2352x1568px — 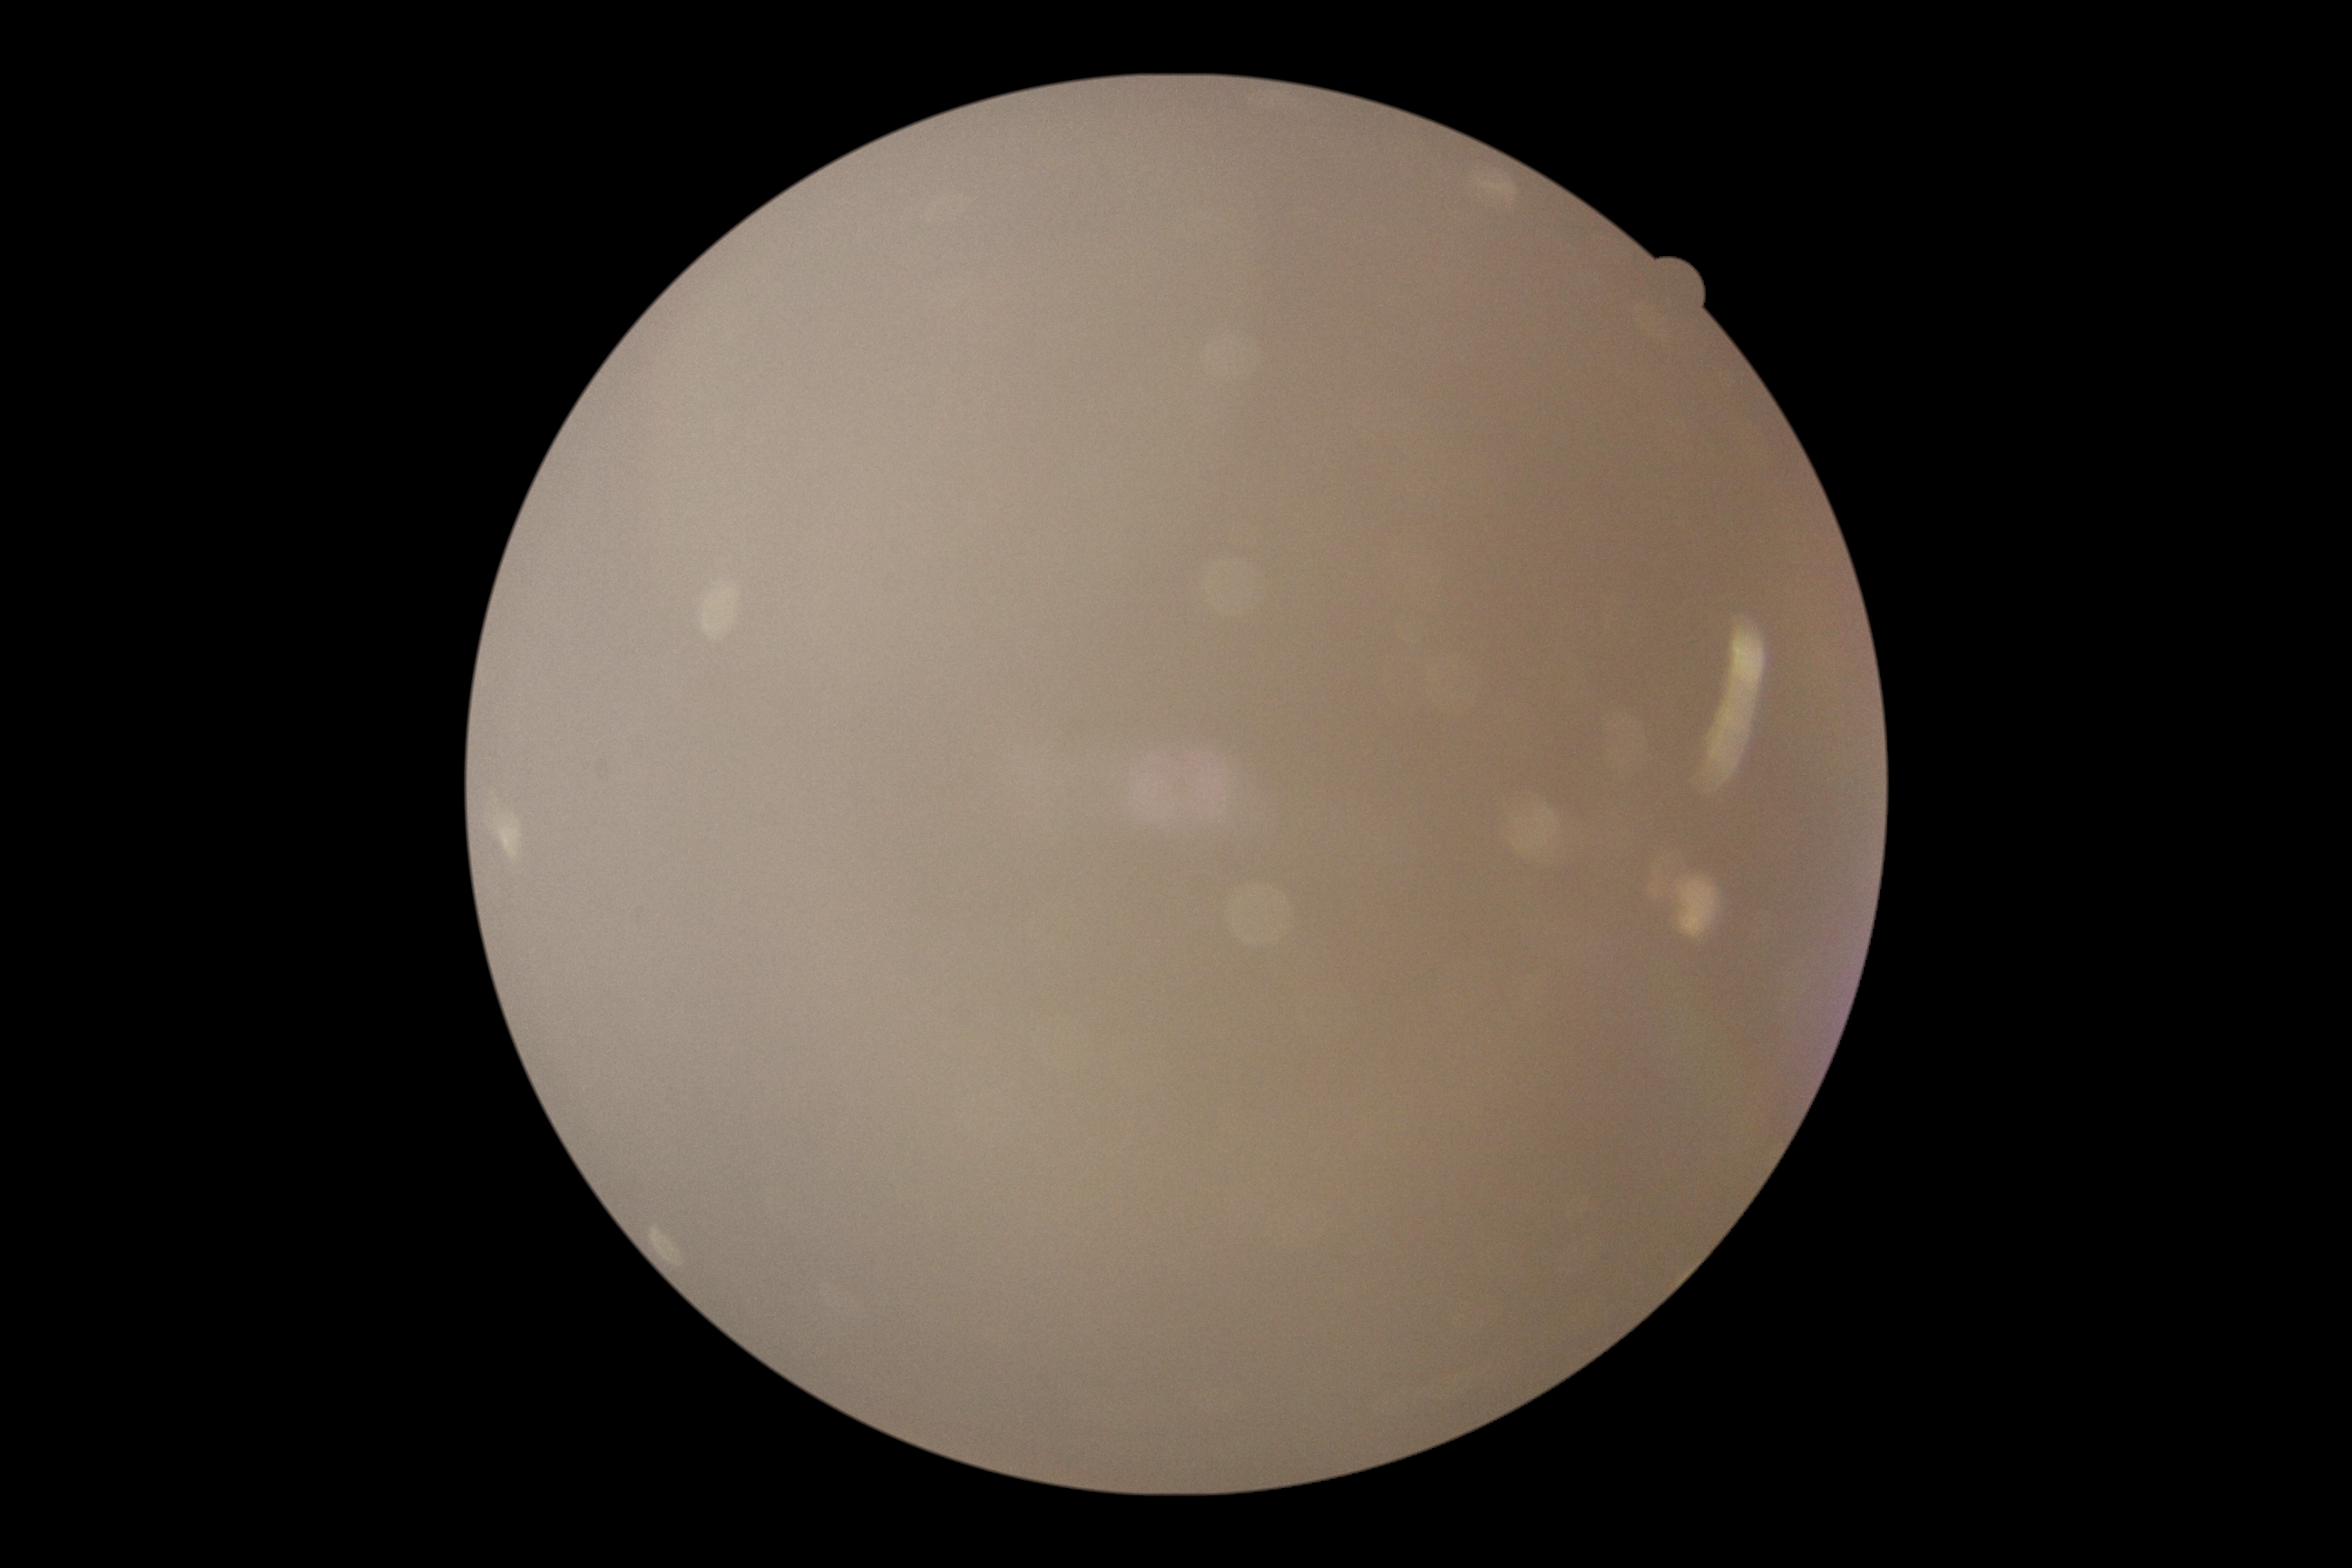
Findings:
* diabetic retinopathy (DR) — ungradable